45 degree fundus photograph, modified Davis classification, image size 848x848
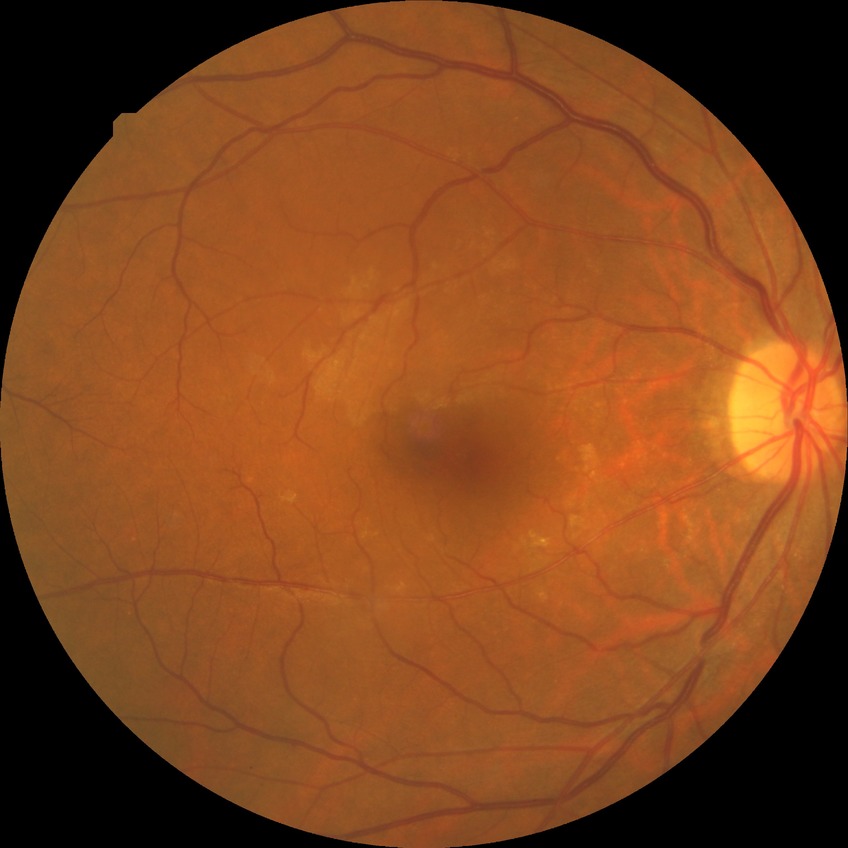
diabetic retinopathy severity@no diabetic retinopathy.